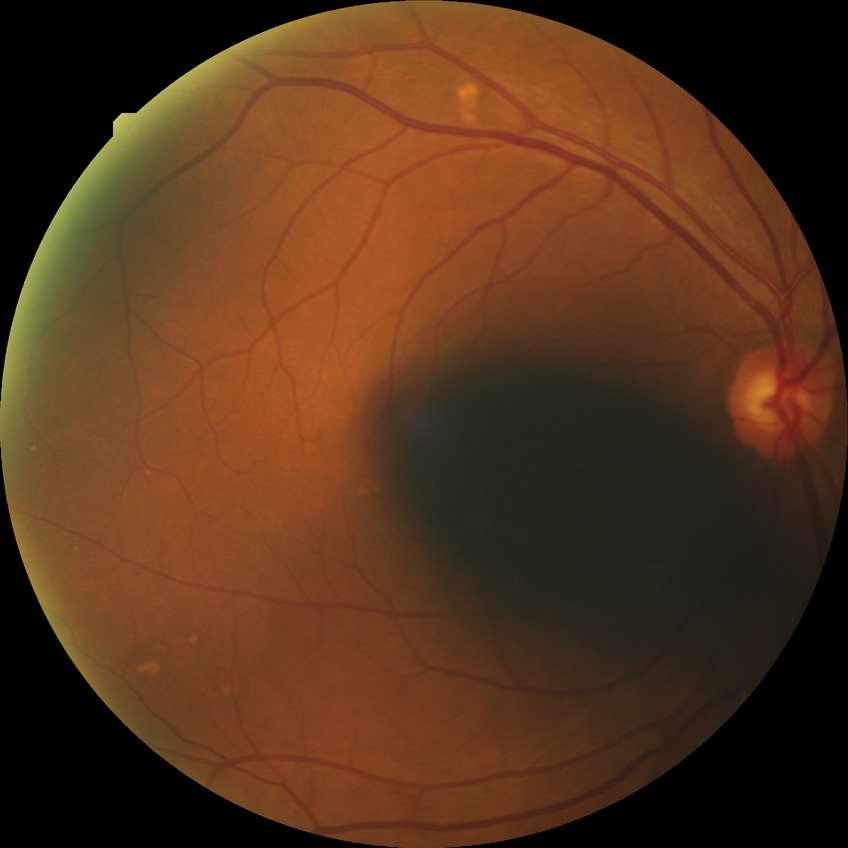

Davis stage is SDR.